Wide-field fundus image from infant ROP screening; 640 x 480 pixels
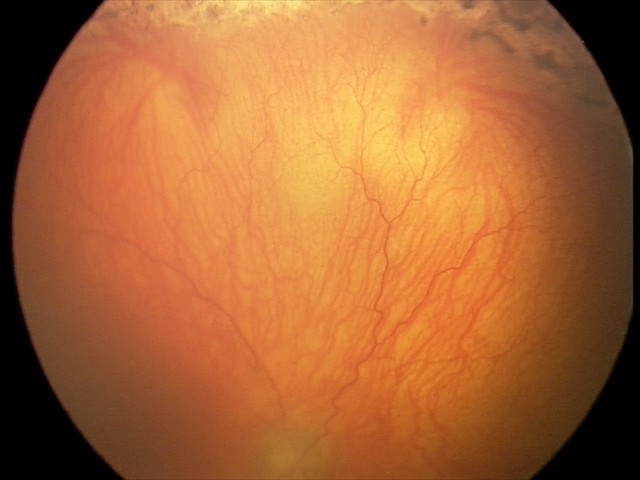

Assessment: plus disease; aggressive retinopathy of prematurity (A-ROP).